Camera: Phoenix ICON (100° FOV) · image size 1240x1240 · infant wide-field fundus photograph
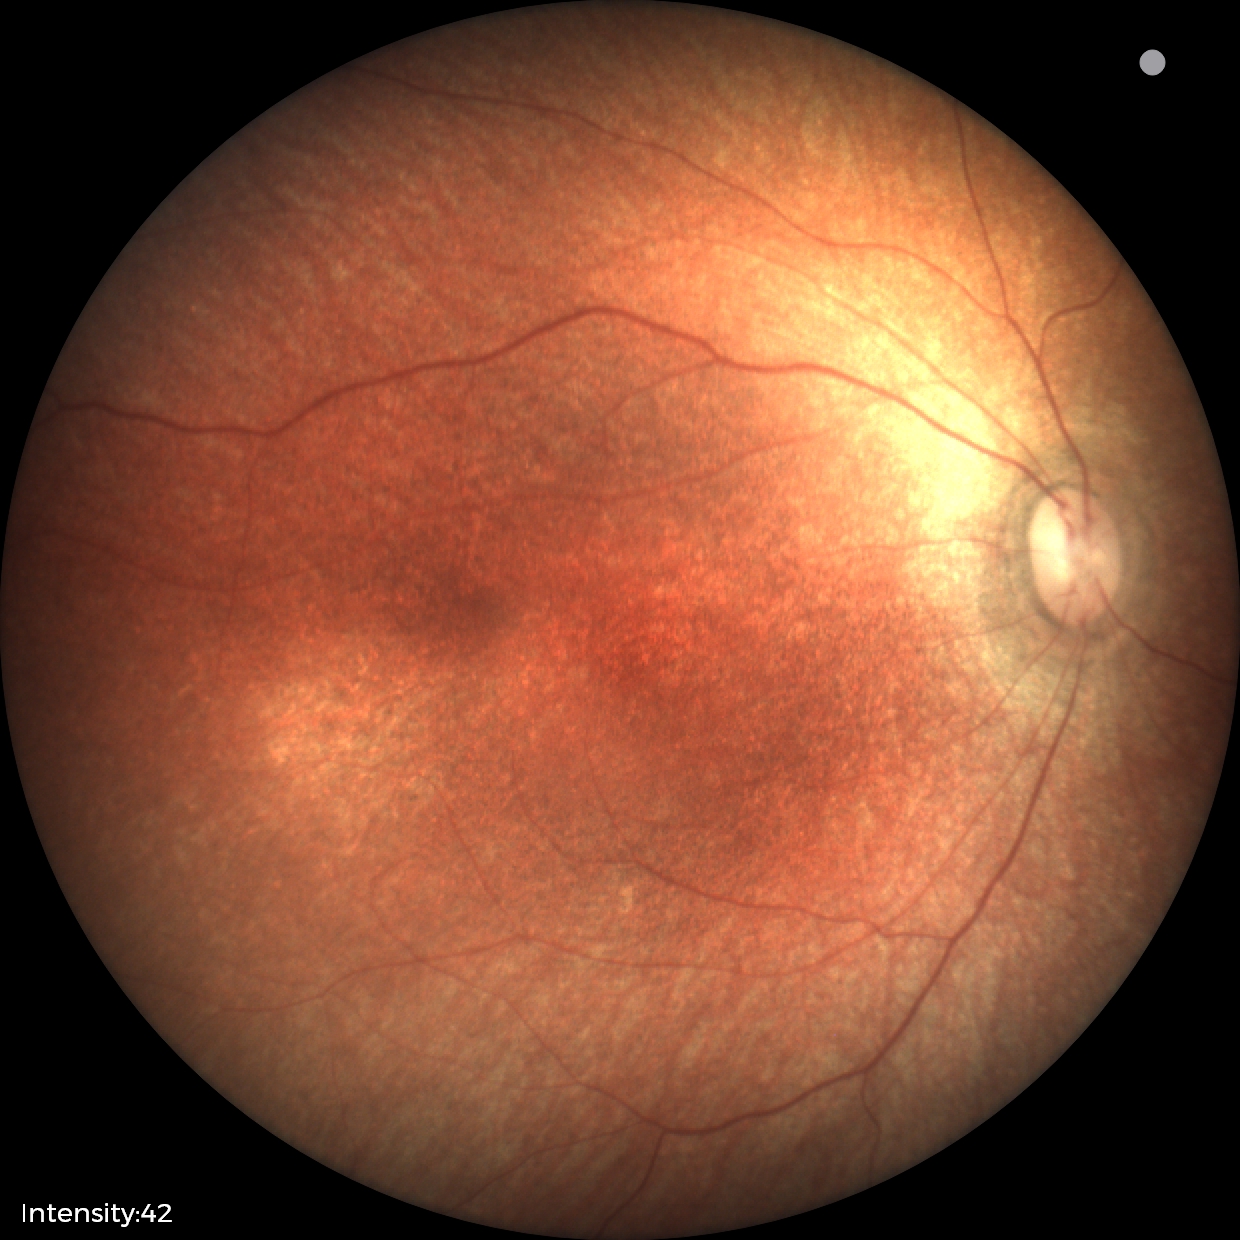
Diagnosis = no pathology identified.